Captured with the Phoenix ICON (100° field of view). 1240x1240. Wide-field fundus image from infant ROP screening.
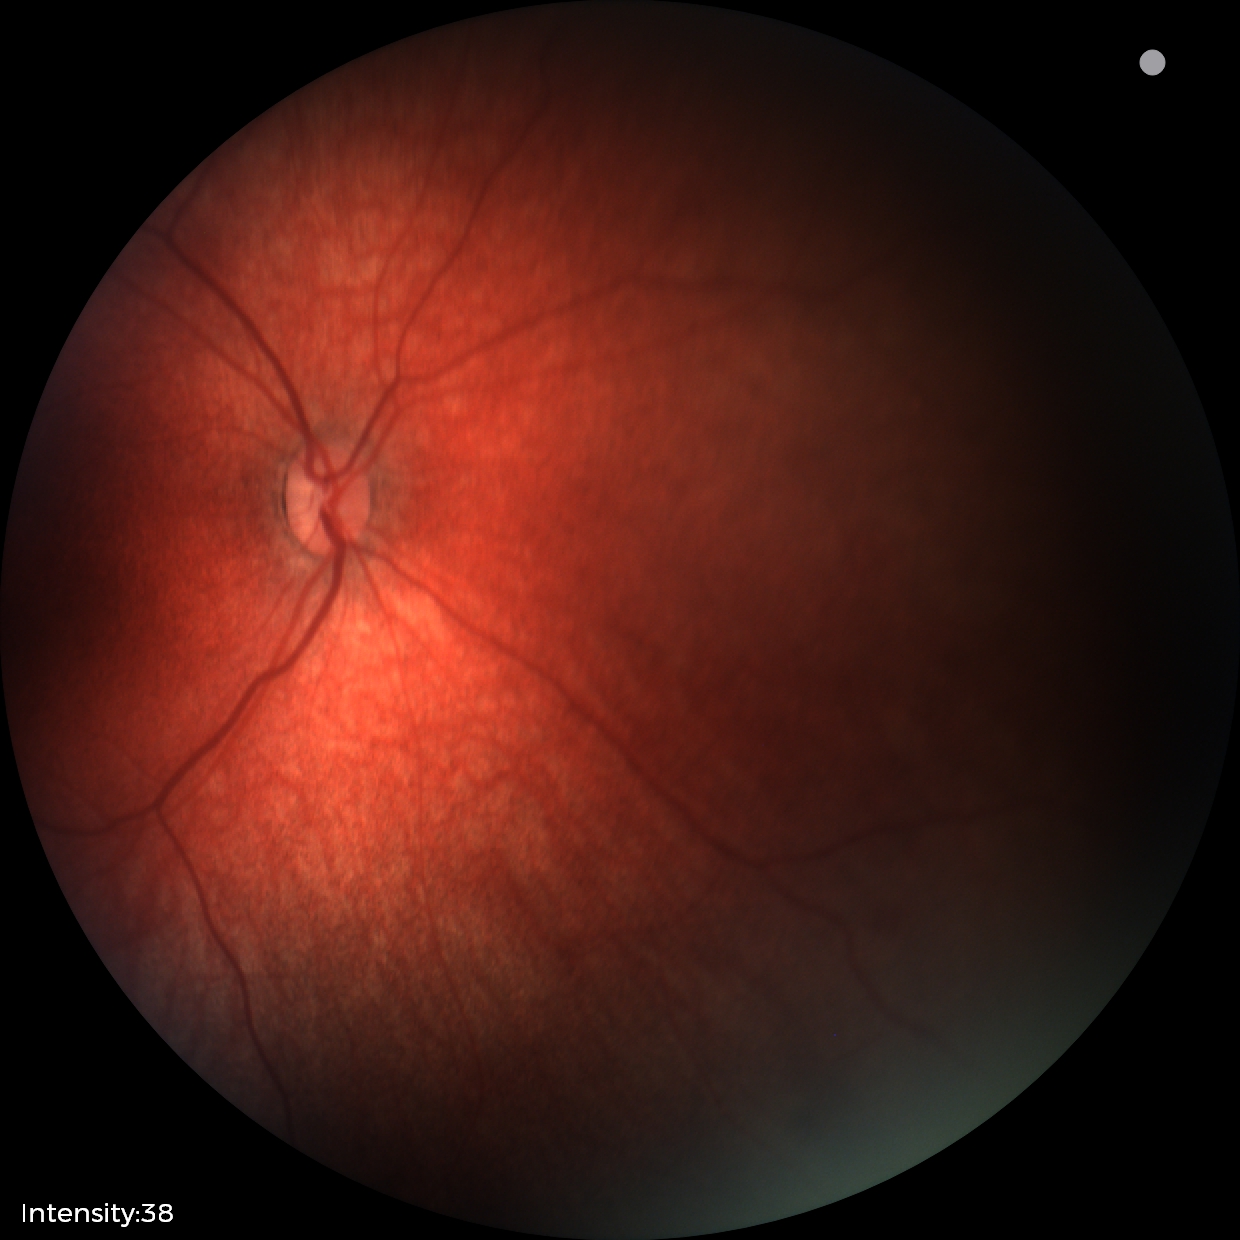

Examination with physiological retinal findings.